Image size 1659x2212: 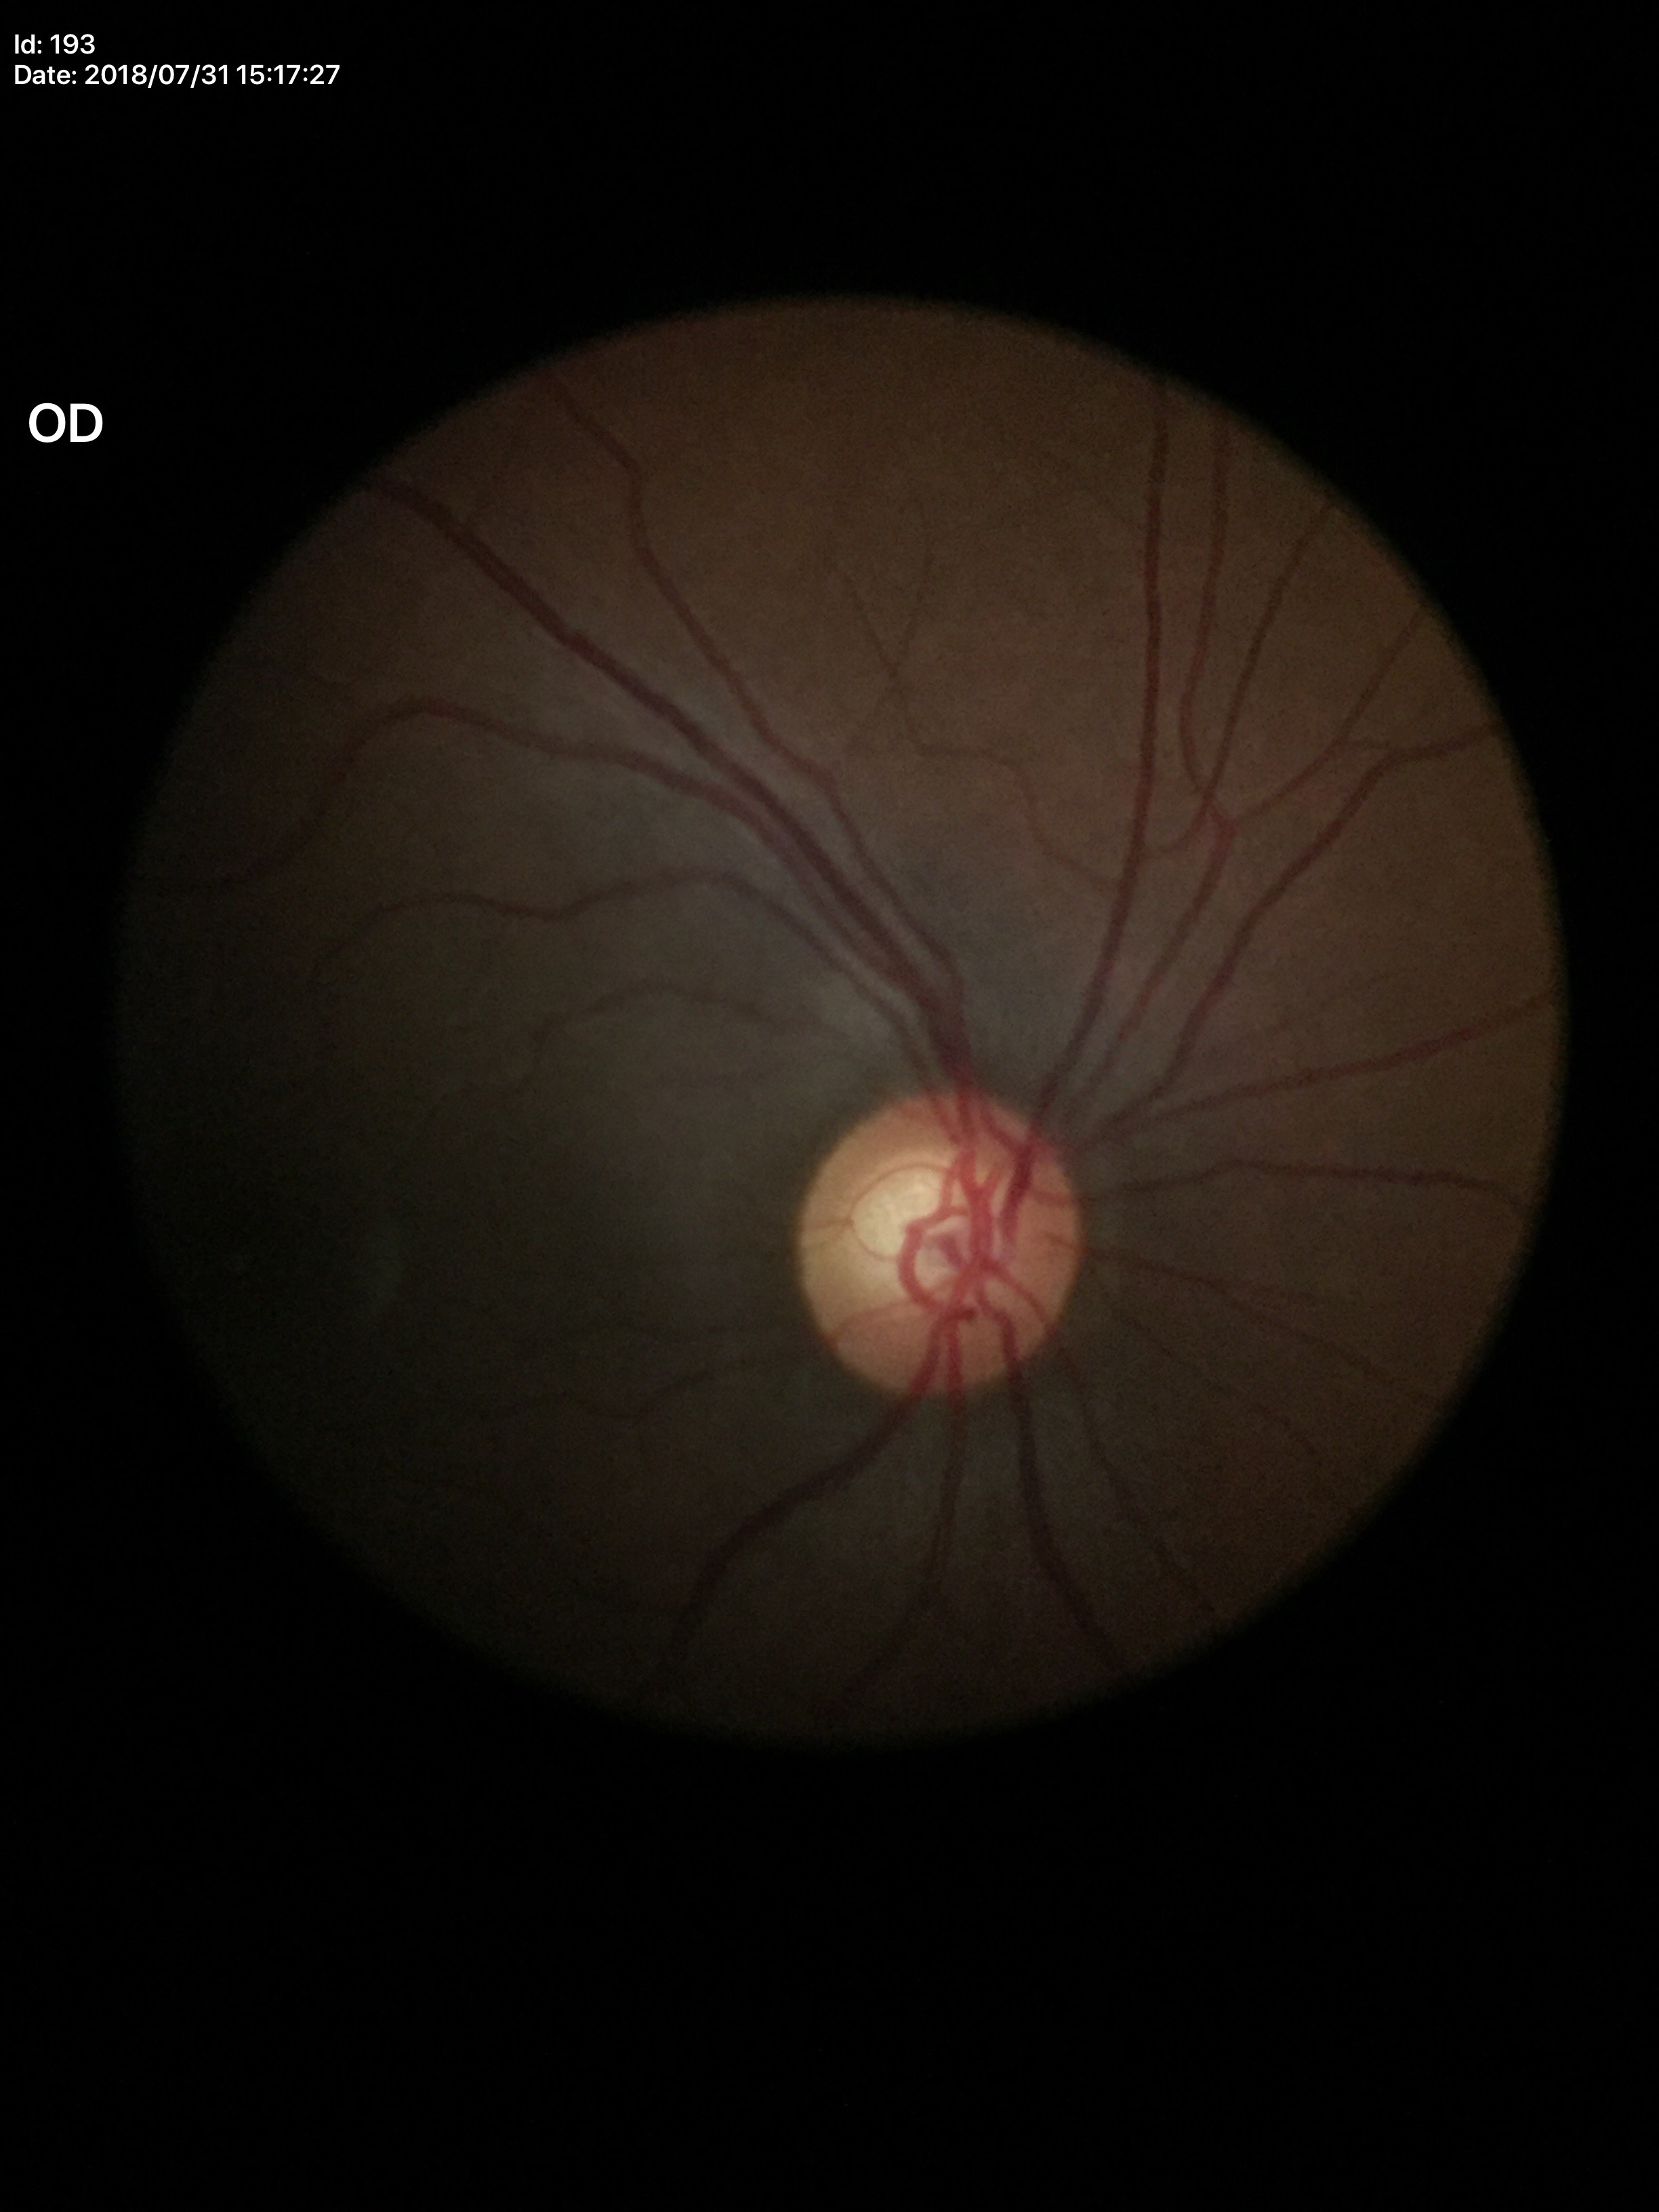 Annotations:
* Glaucoma impression: suspect
* horizontal C/D ratio (HCDR): 0.62
* vertical cup-to-disc ratio (VCDR): 0.63